45° FOV. CFP. 2048x1536px
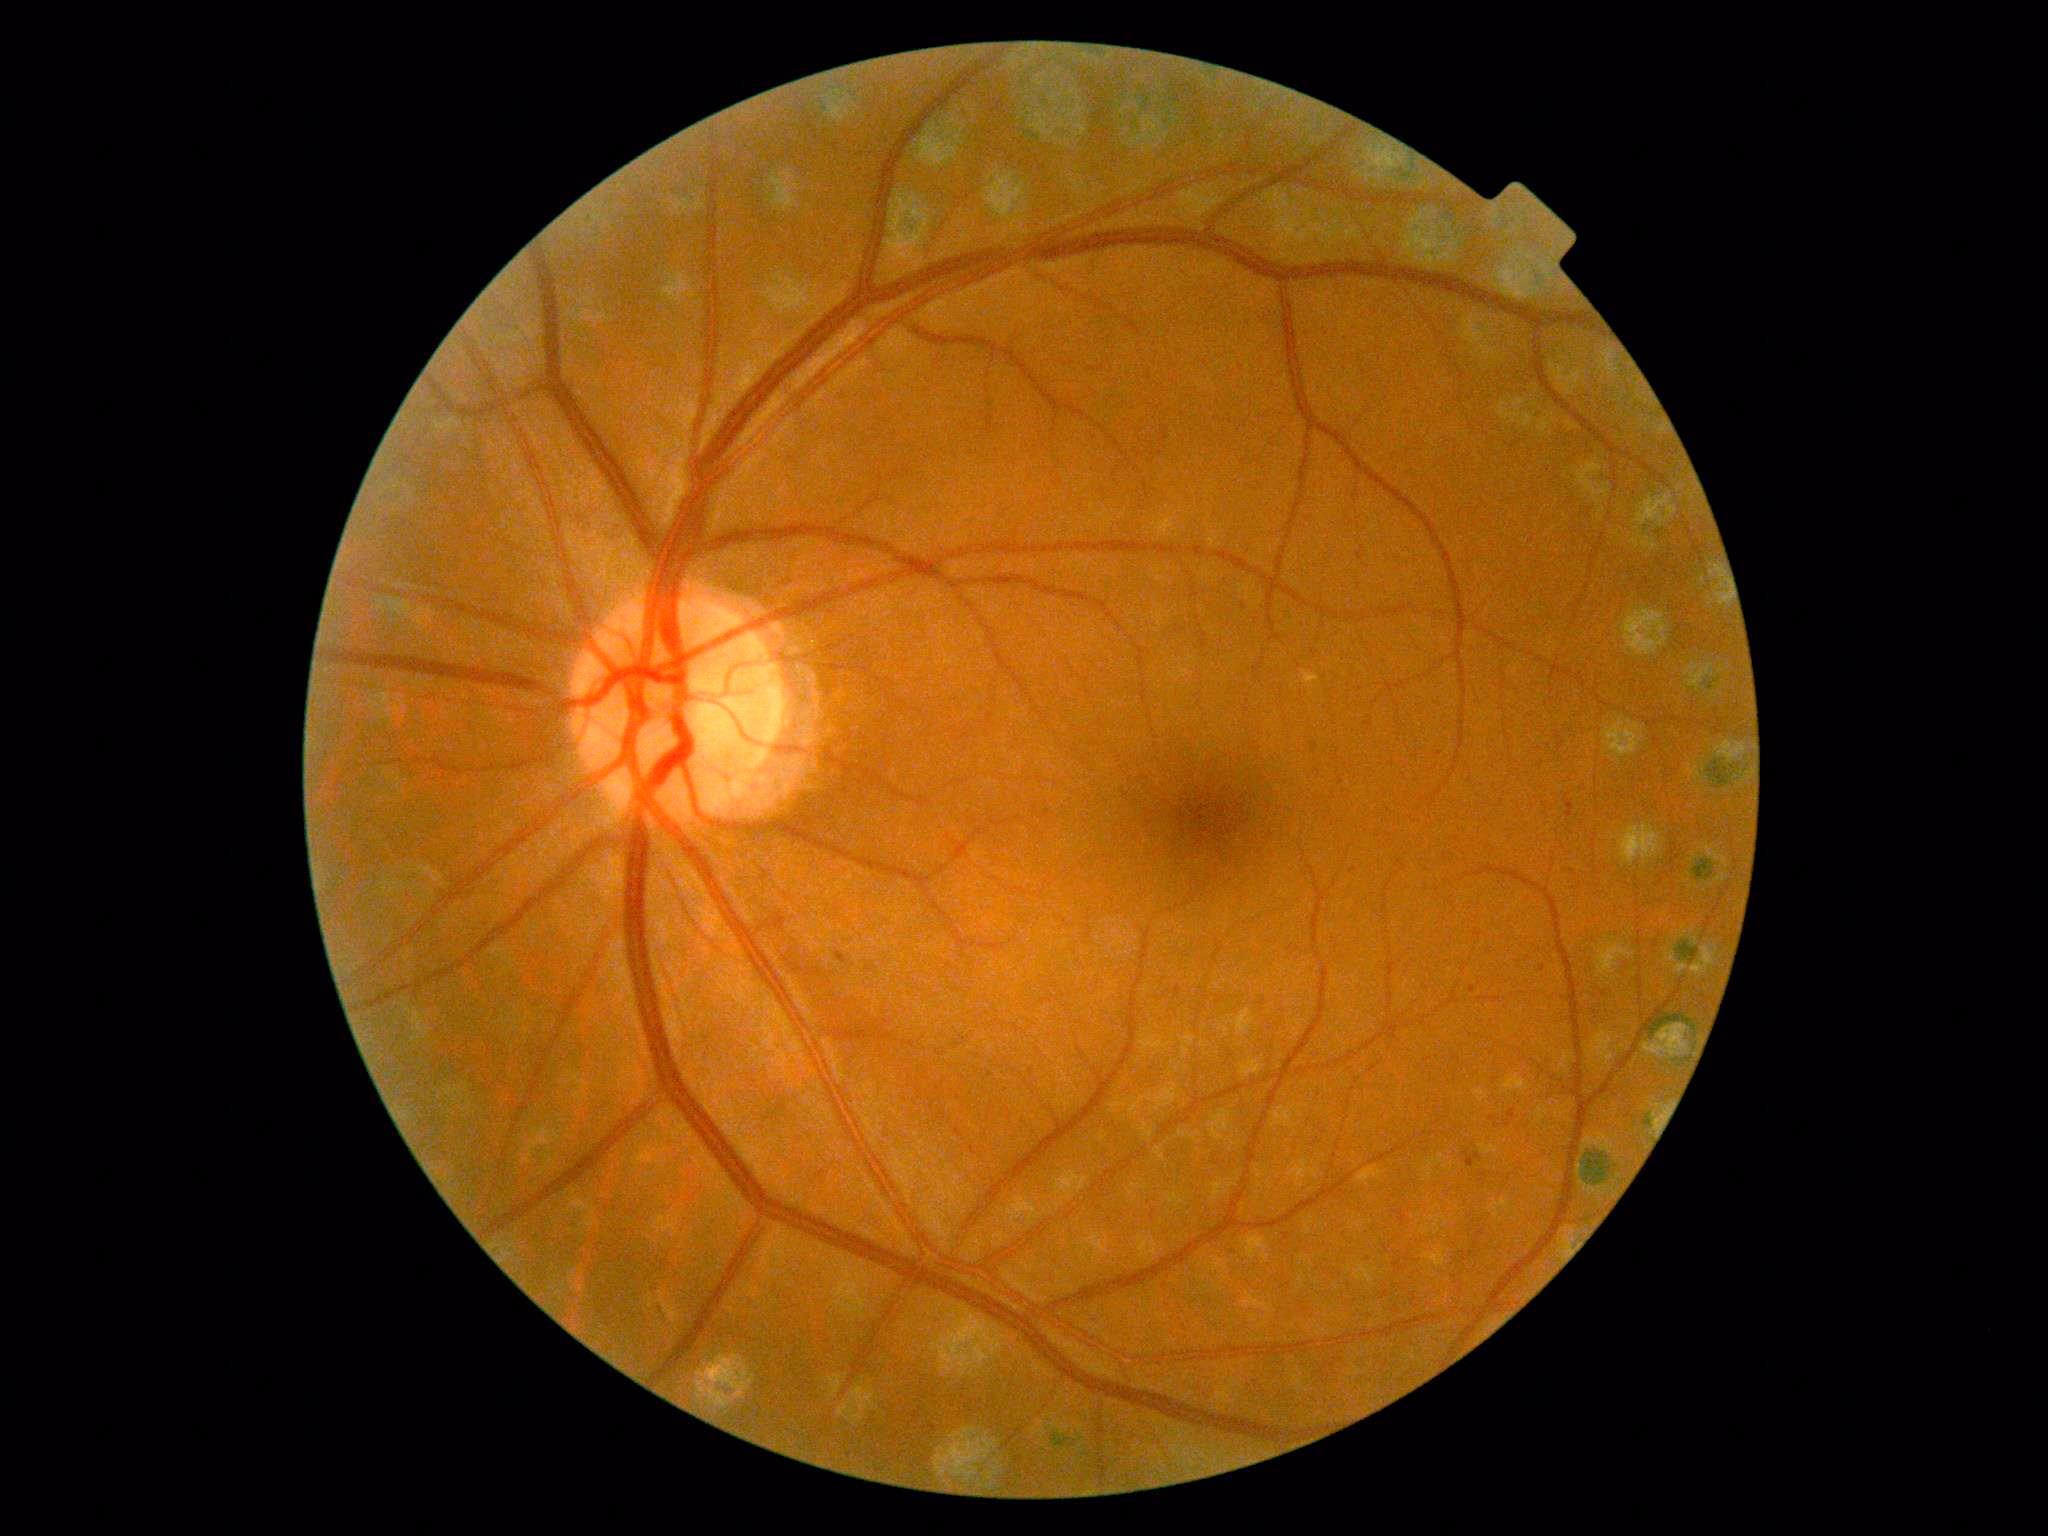

Diabetic retinopathy (DR) is 2 — more than just microaneurysms but less than severe NPDR. The retinopathy is classified as non-proliferative diabetic retinopathy.